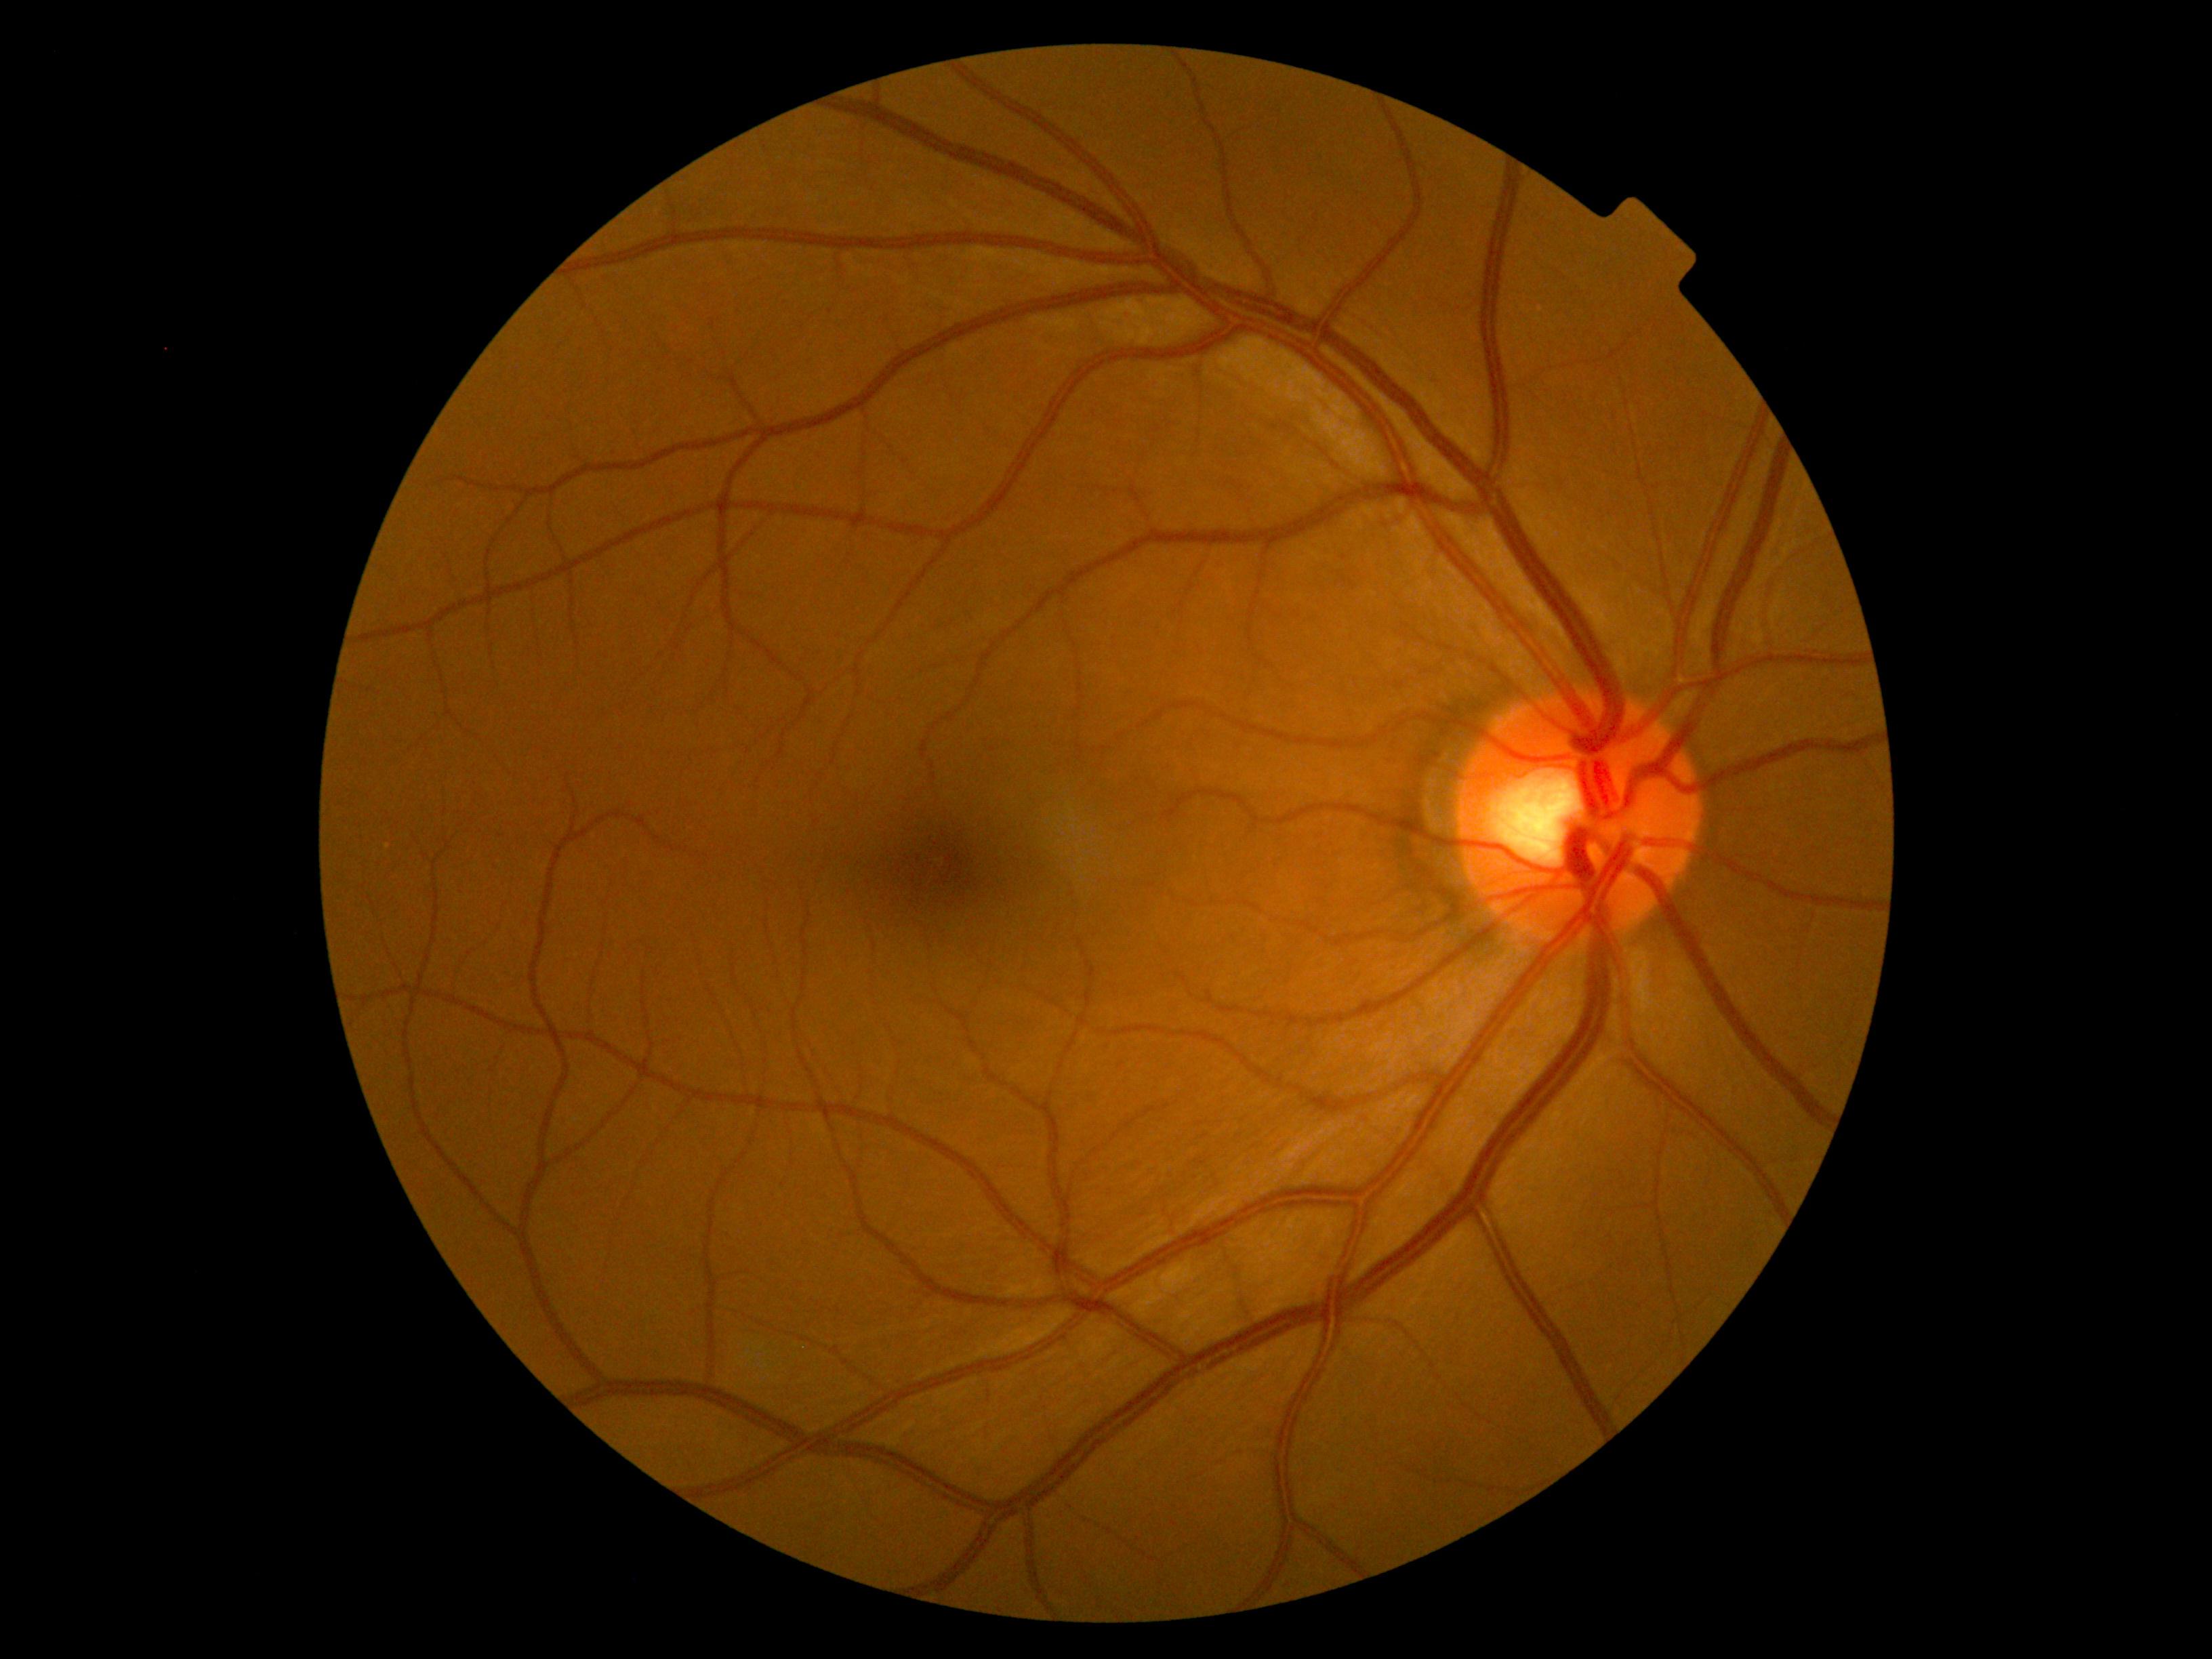
DR grade is 0. No diabetic retinal disease findings.